45° FOV. 2352x1568px. Retinal fundus photograph — 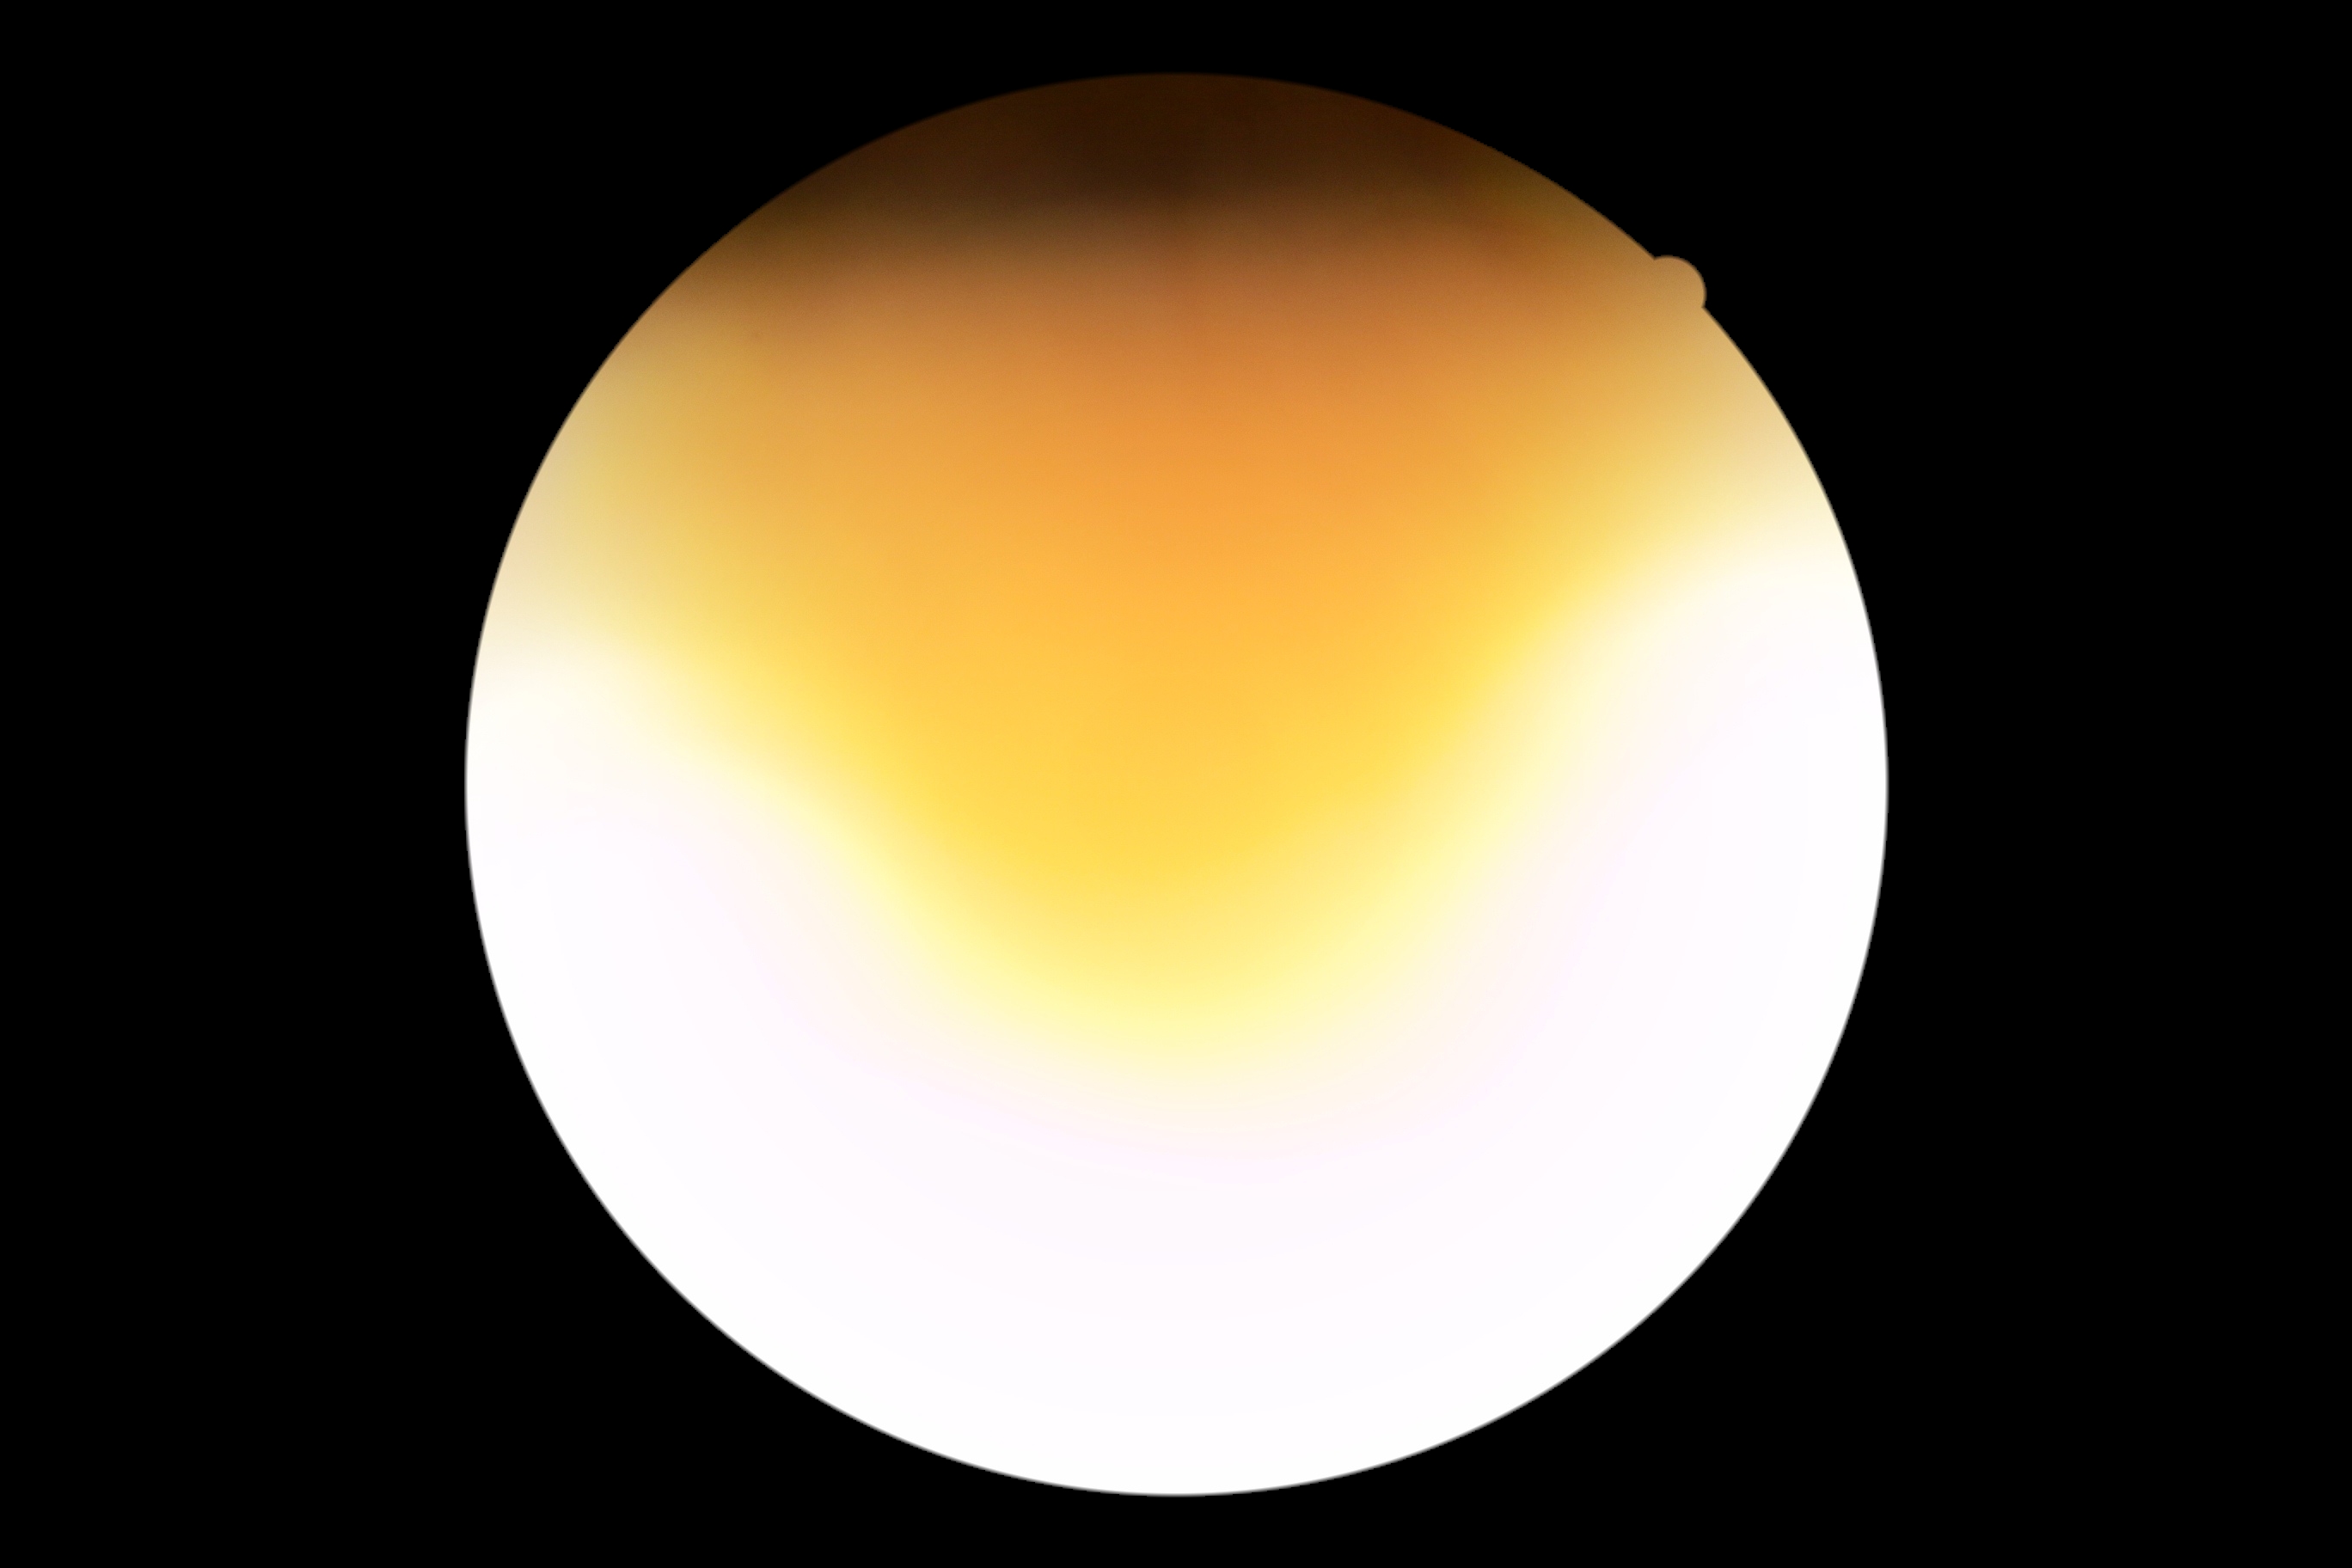

Findings:
– DR stage — ungradable due to poor image quality
– image quality — below grading threshold